45-degree field of view, 2352 x 1568 pixels — 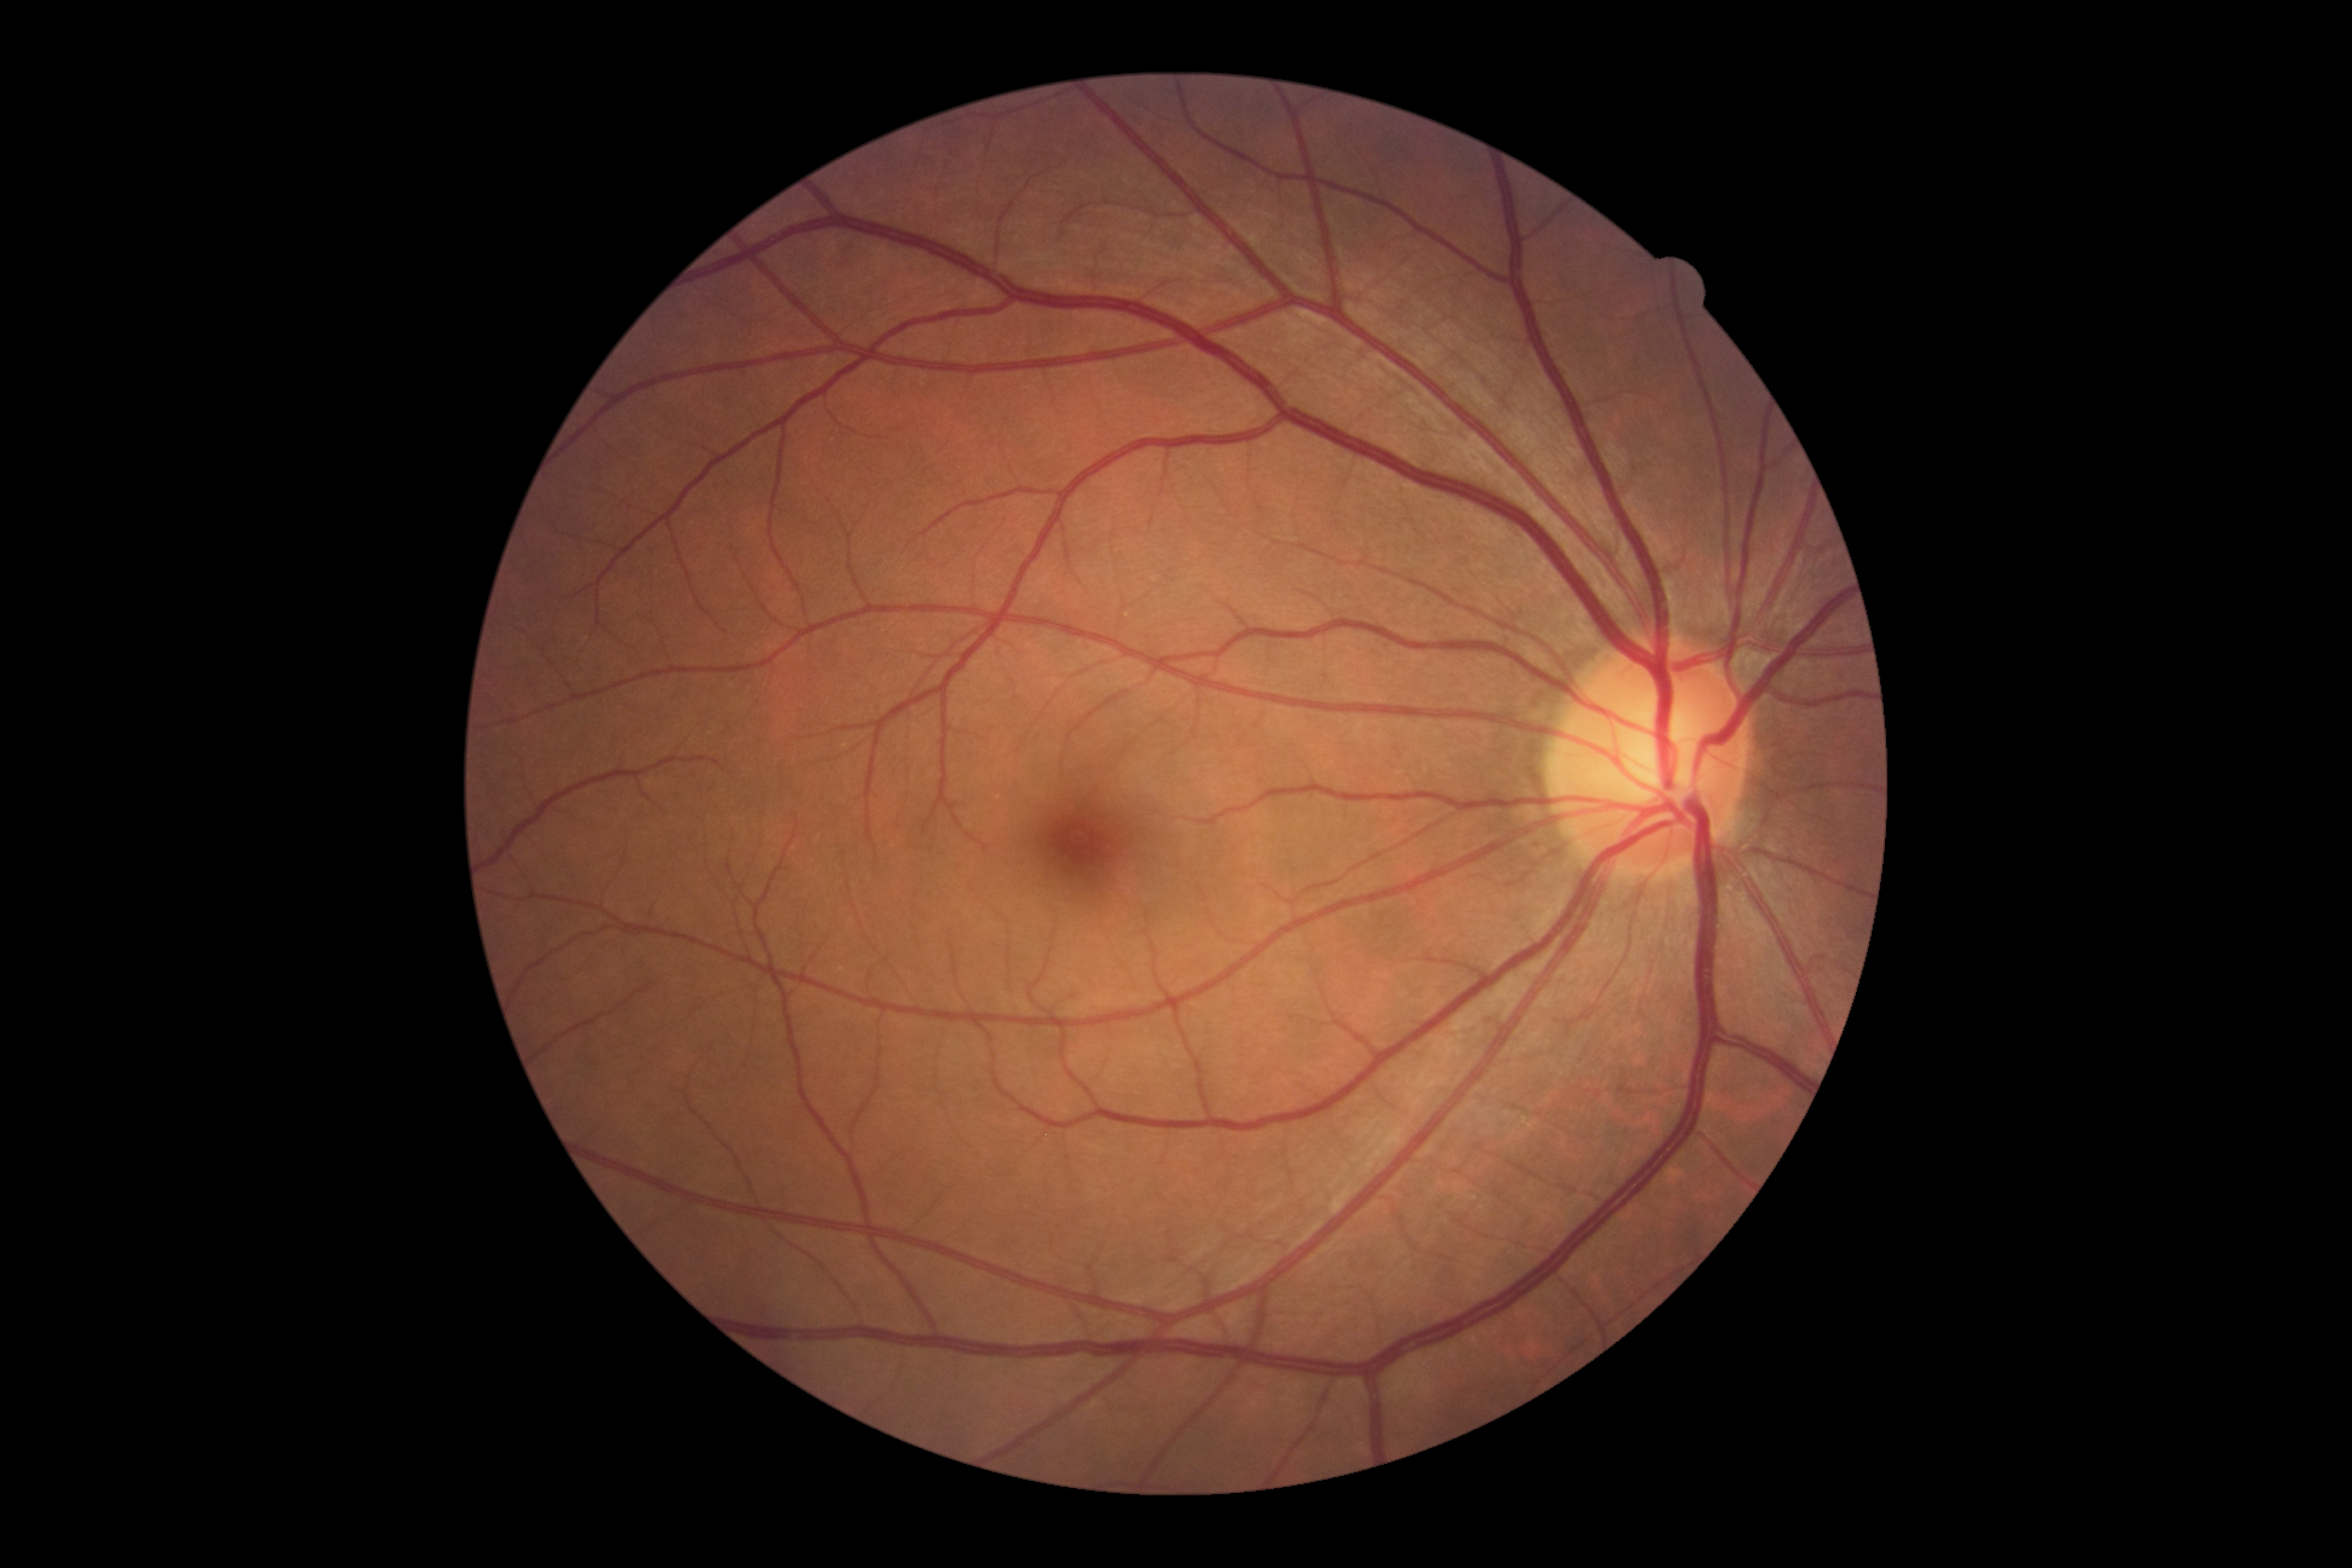
Diabetic retinopathy (DR) is no apparent retinopathy (grade 0).